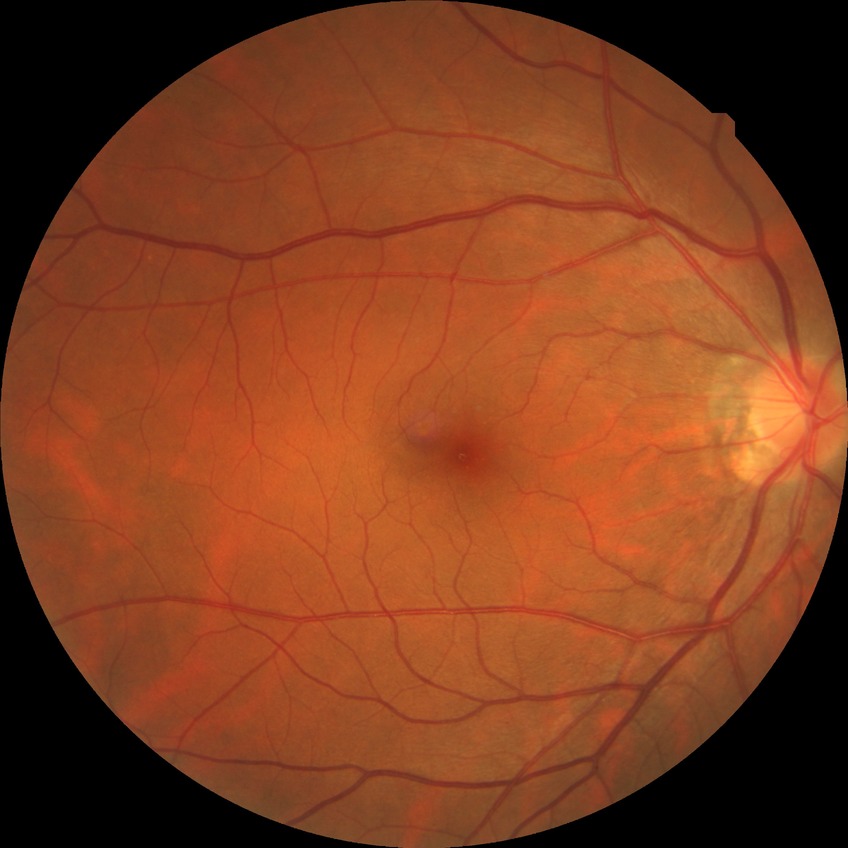 Diabetic retinopathy (DR) is no diabetic retinopathy (NDR).